2352 by 1568 pixels · 45° FOV · color fundus photograph: 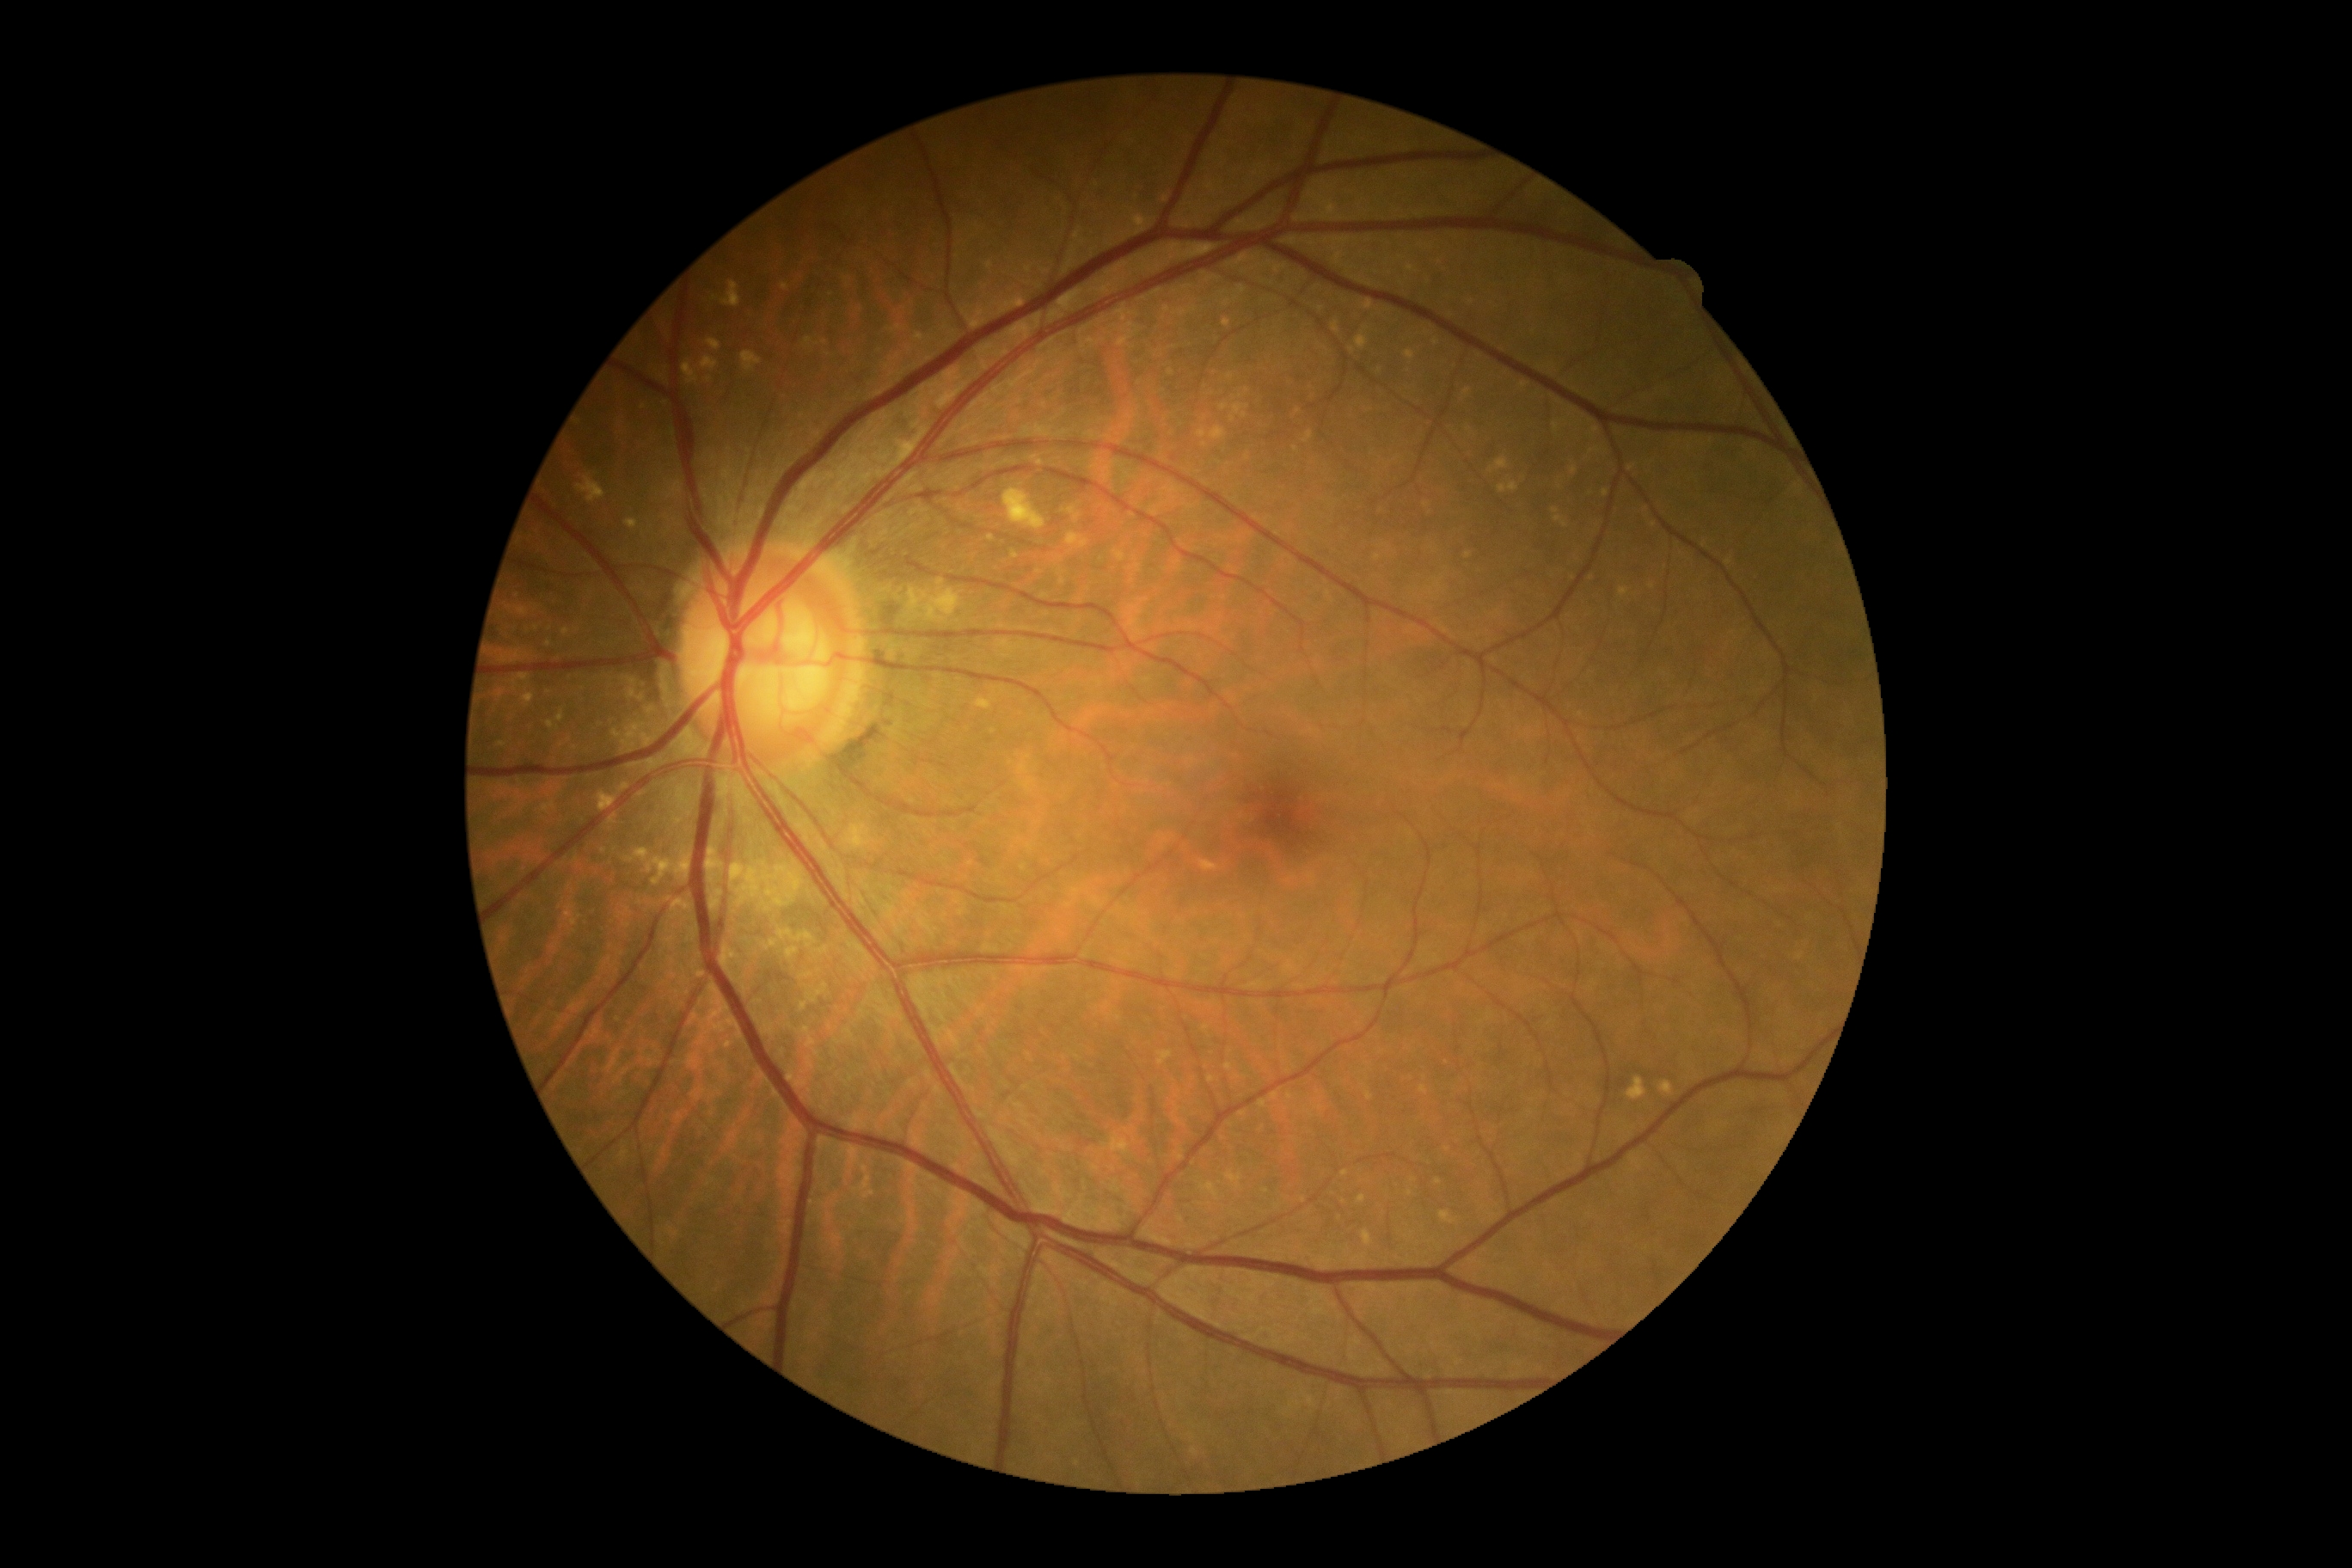
DR severity: grade 0 (no apparent retinopathy).